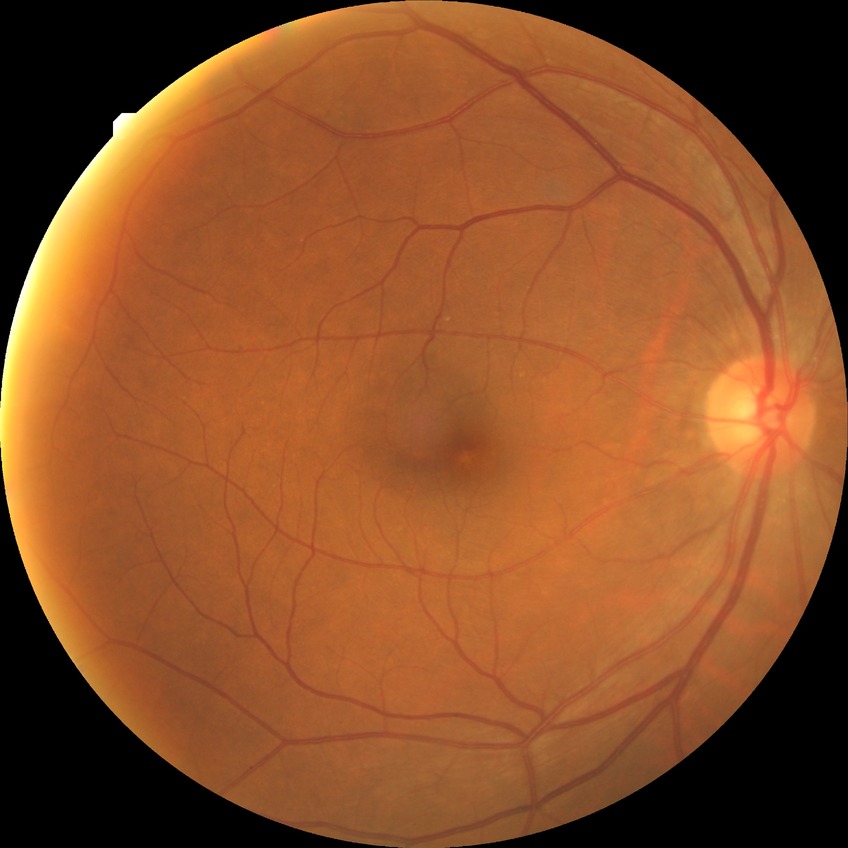
Modified Davis grading is no diabetic retinopathy.